45-degree field of view. 2352x1568.
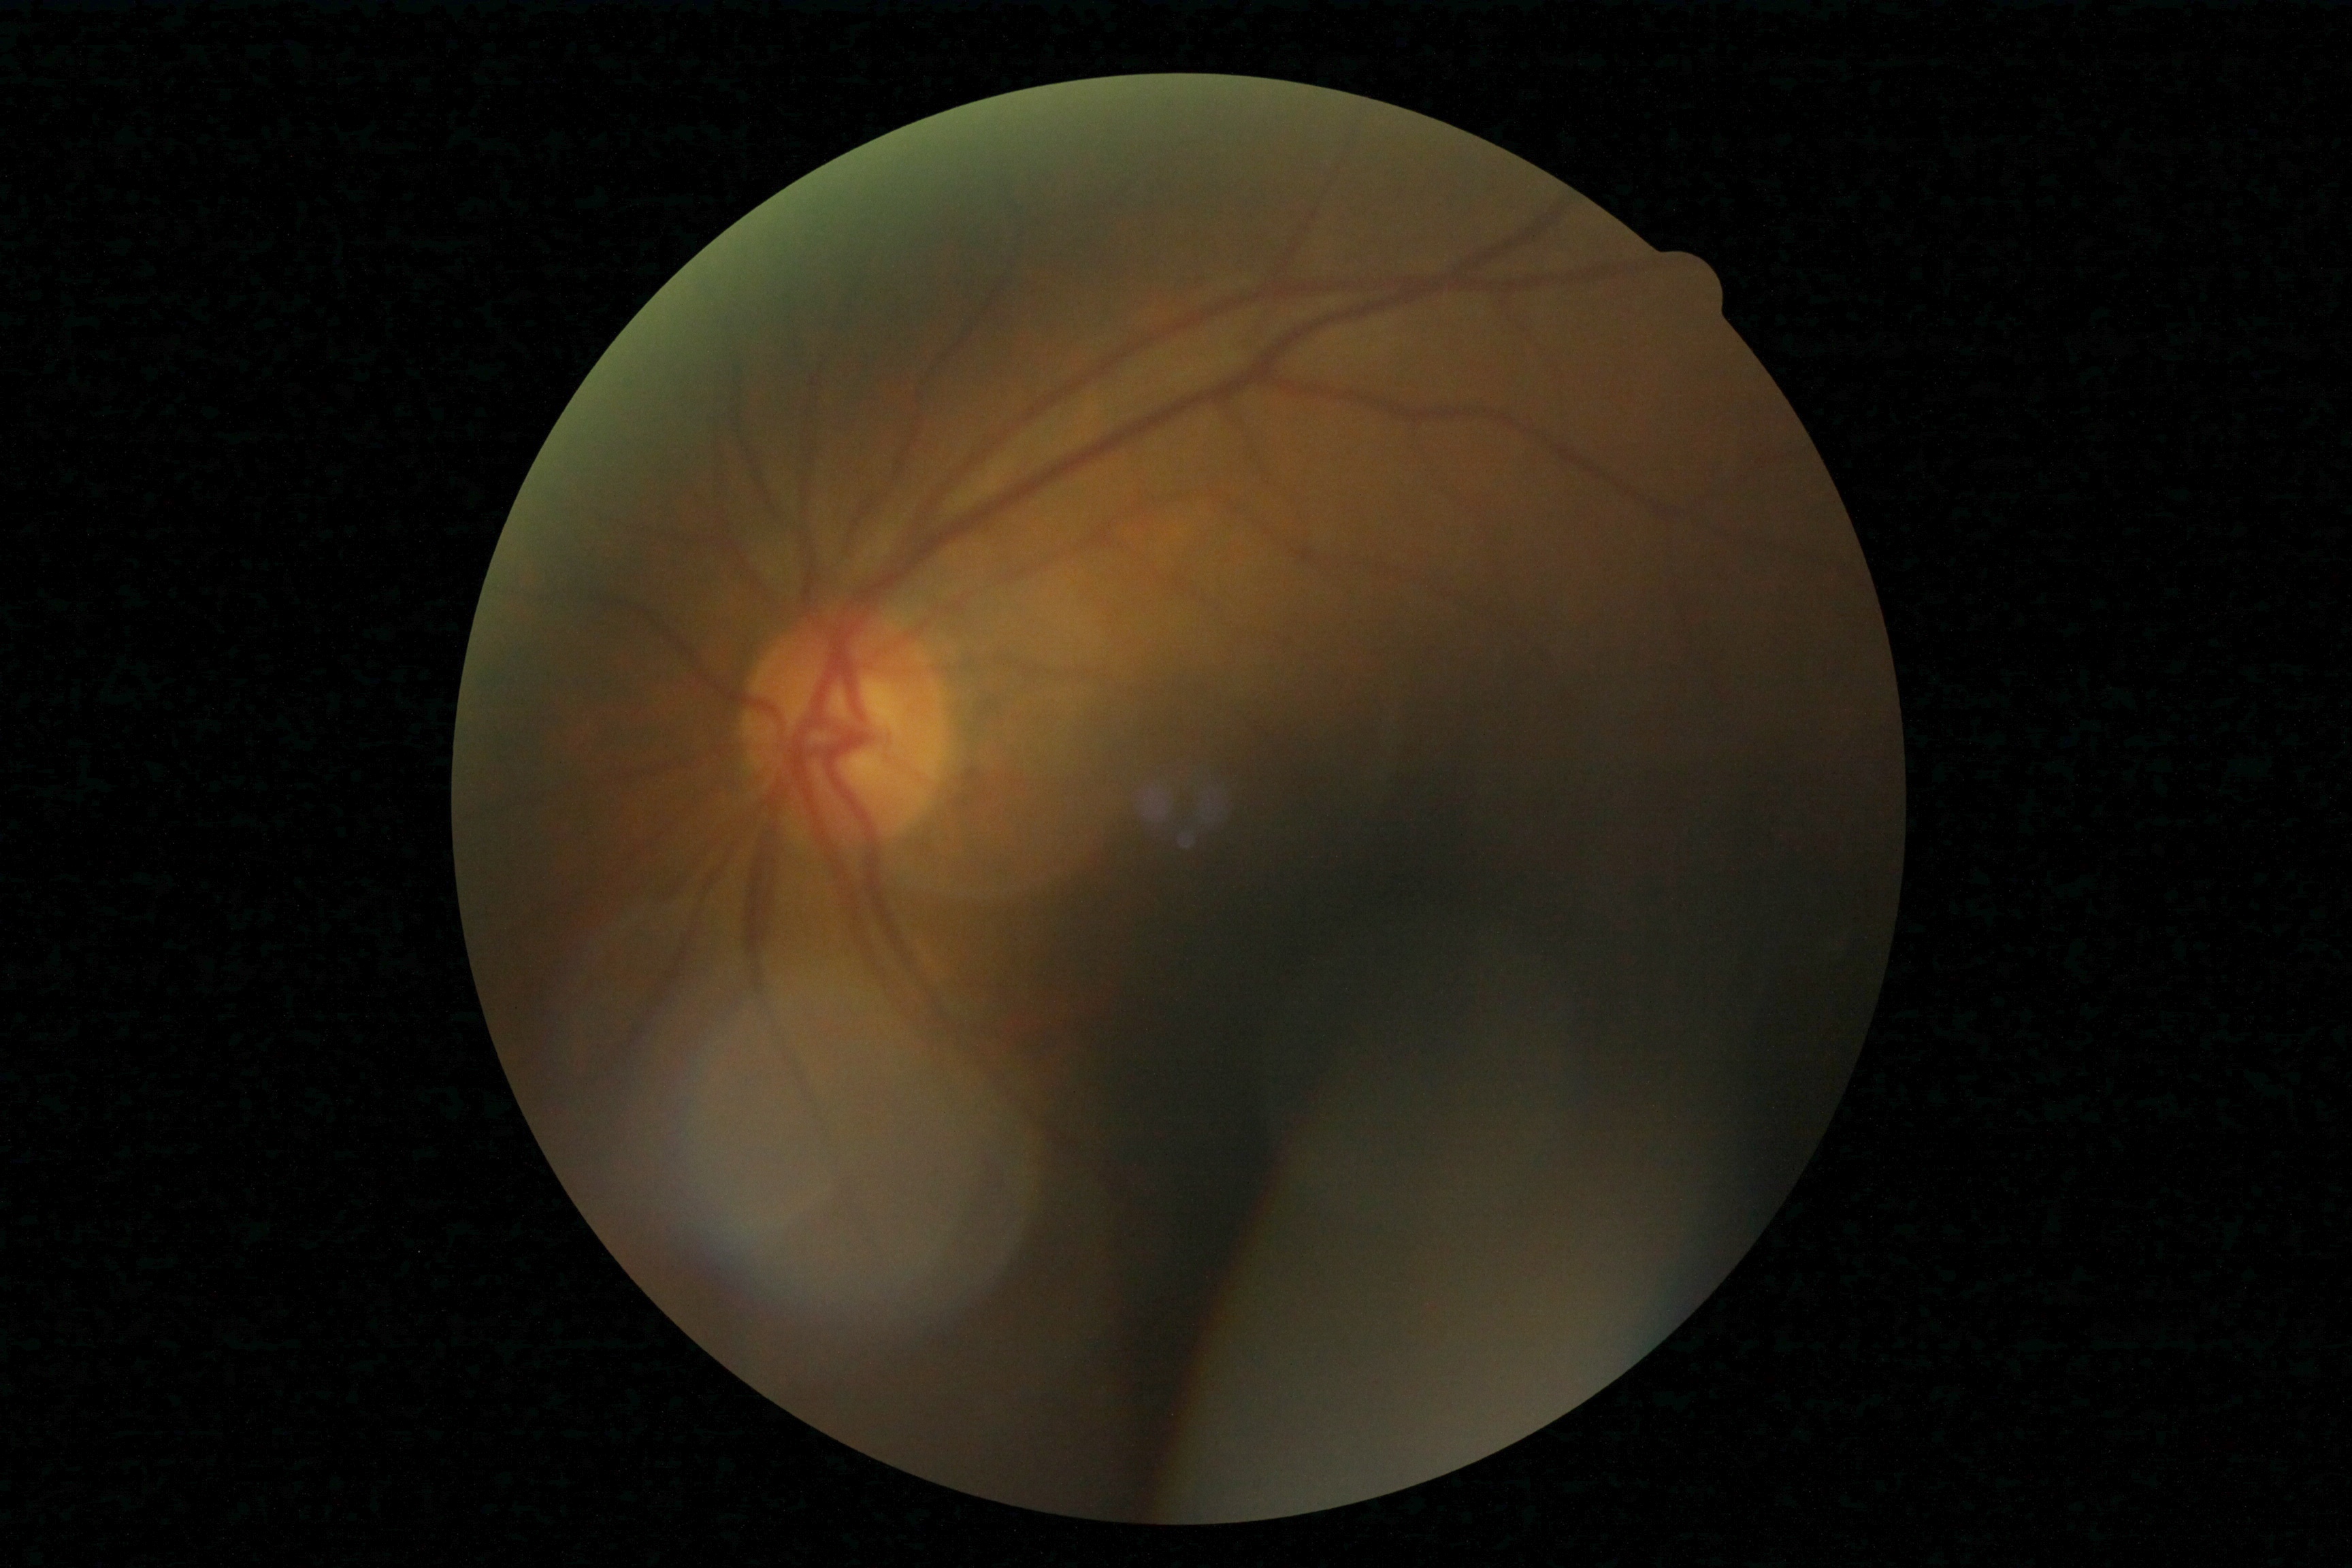 dr_grade: 0/4